1240x1240. Pediatric wide-field fundus photograph.
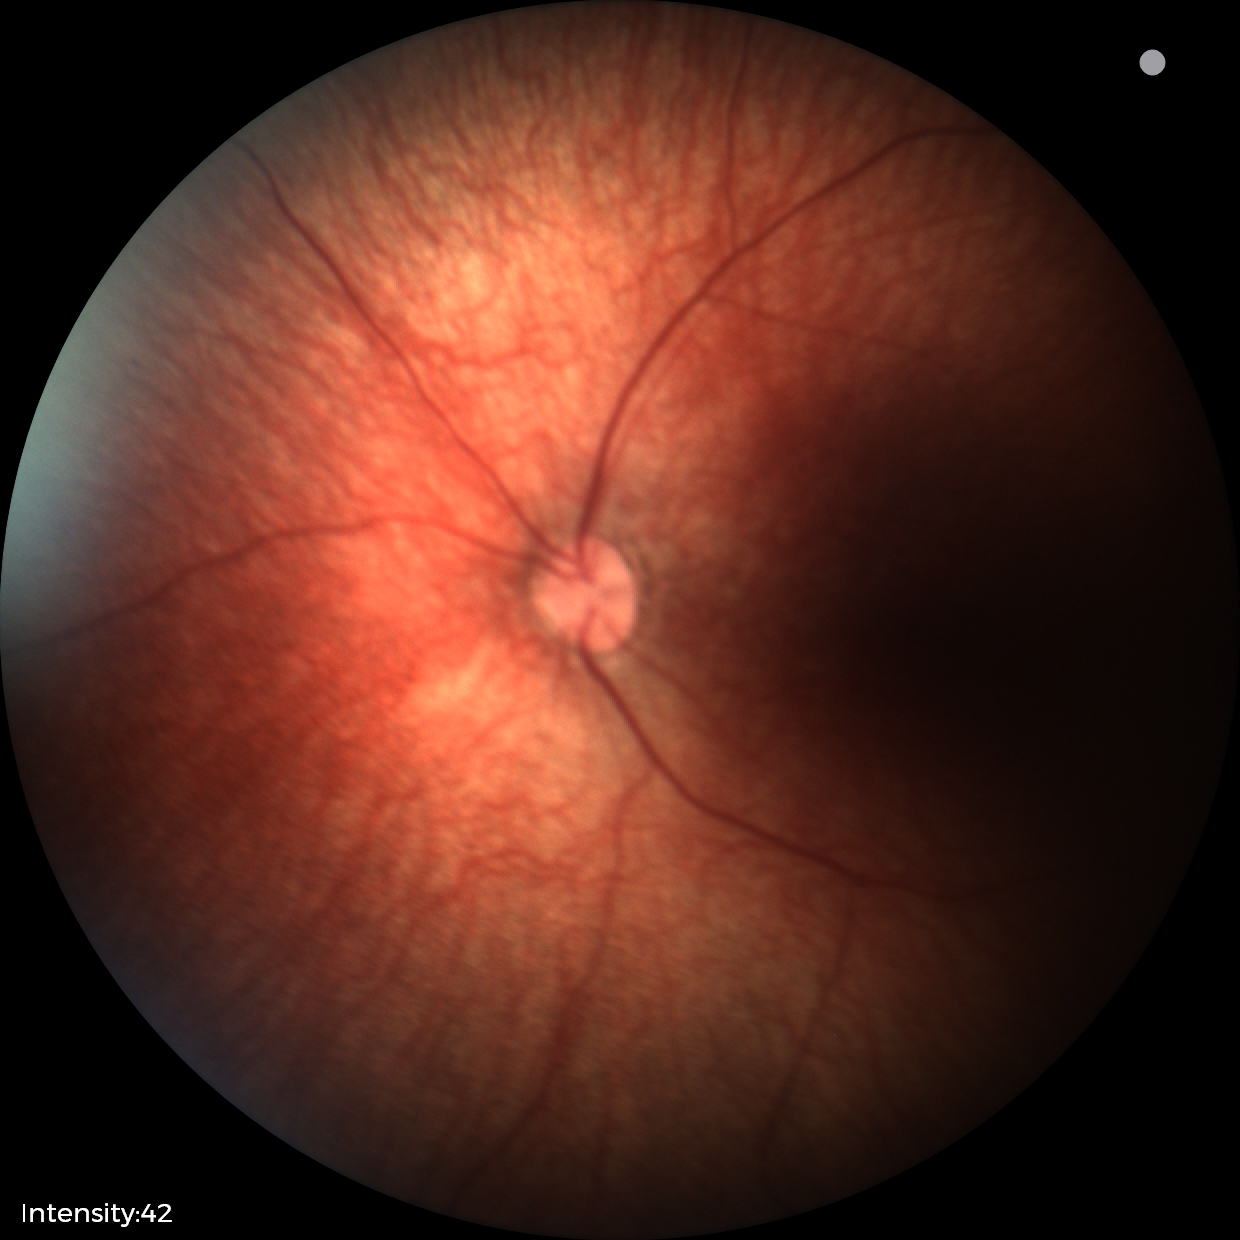 Examination with physiological retinal findings.